Posterior pole color fundus photograph
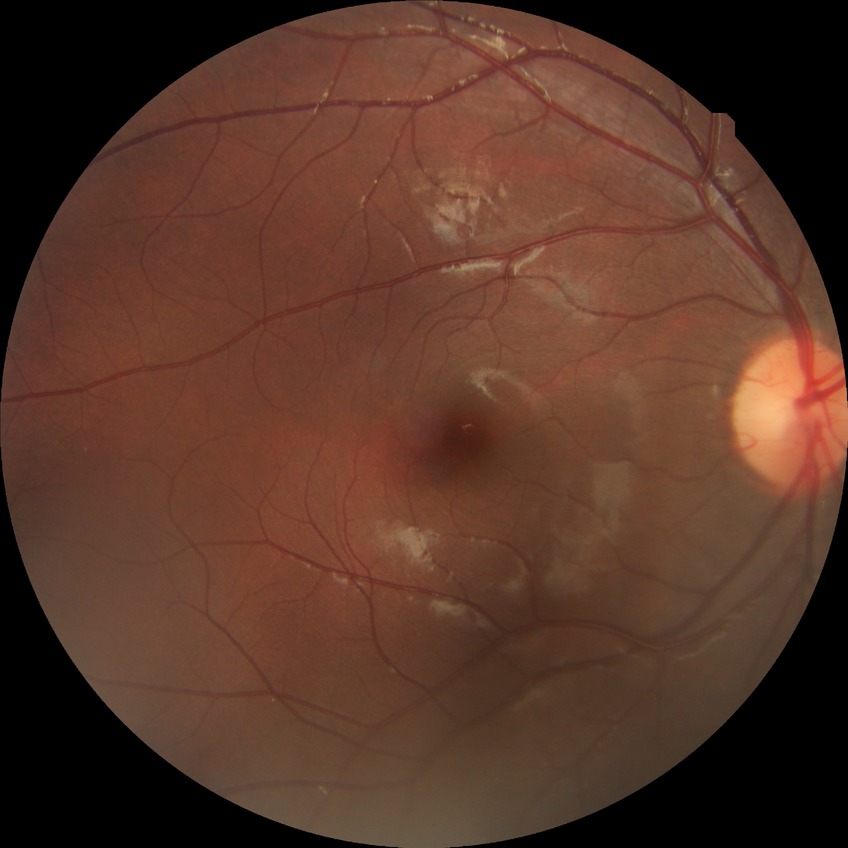

{
  "davis_grade": "no diabetic retinopathy"
}